1932 by 1910 pixels; color fundus photograph.
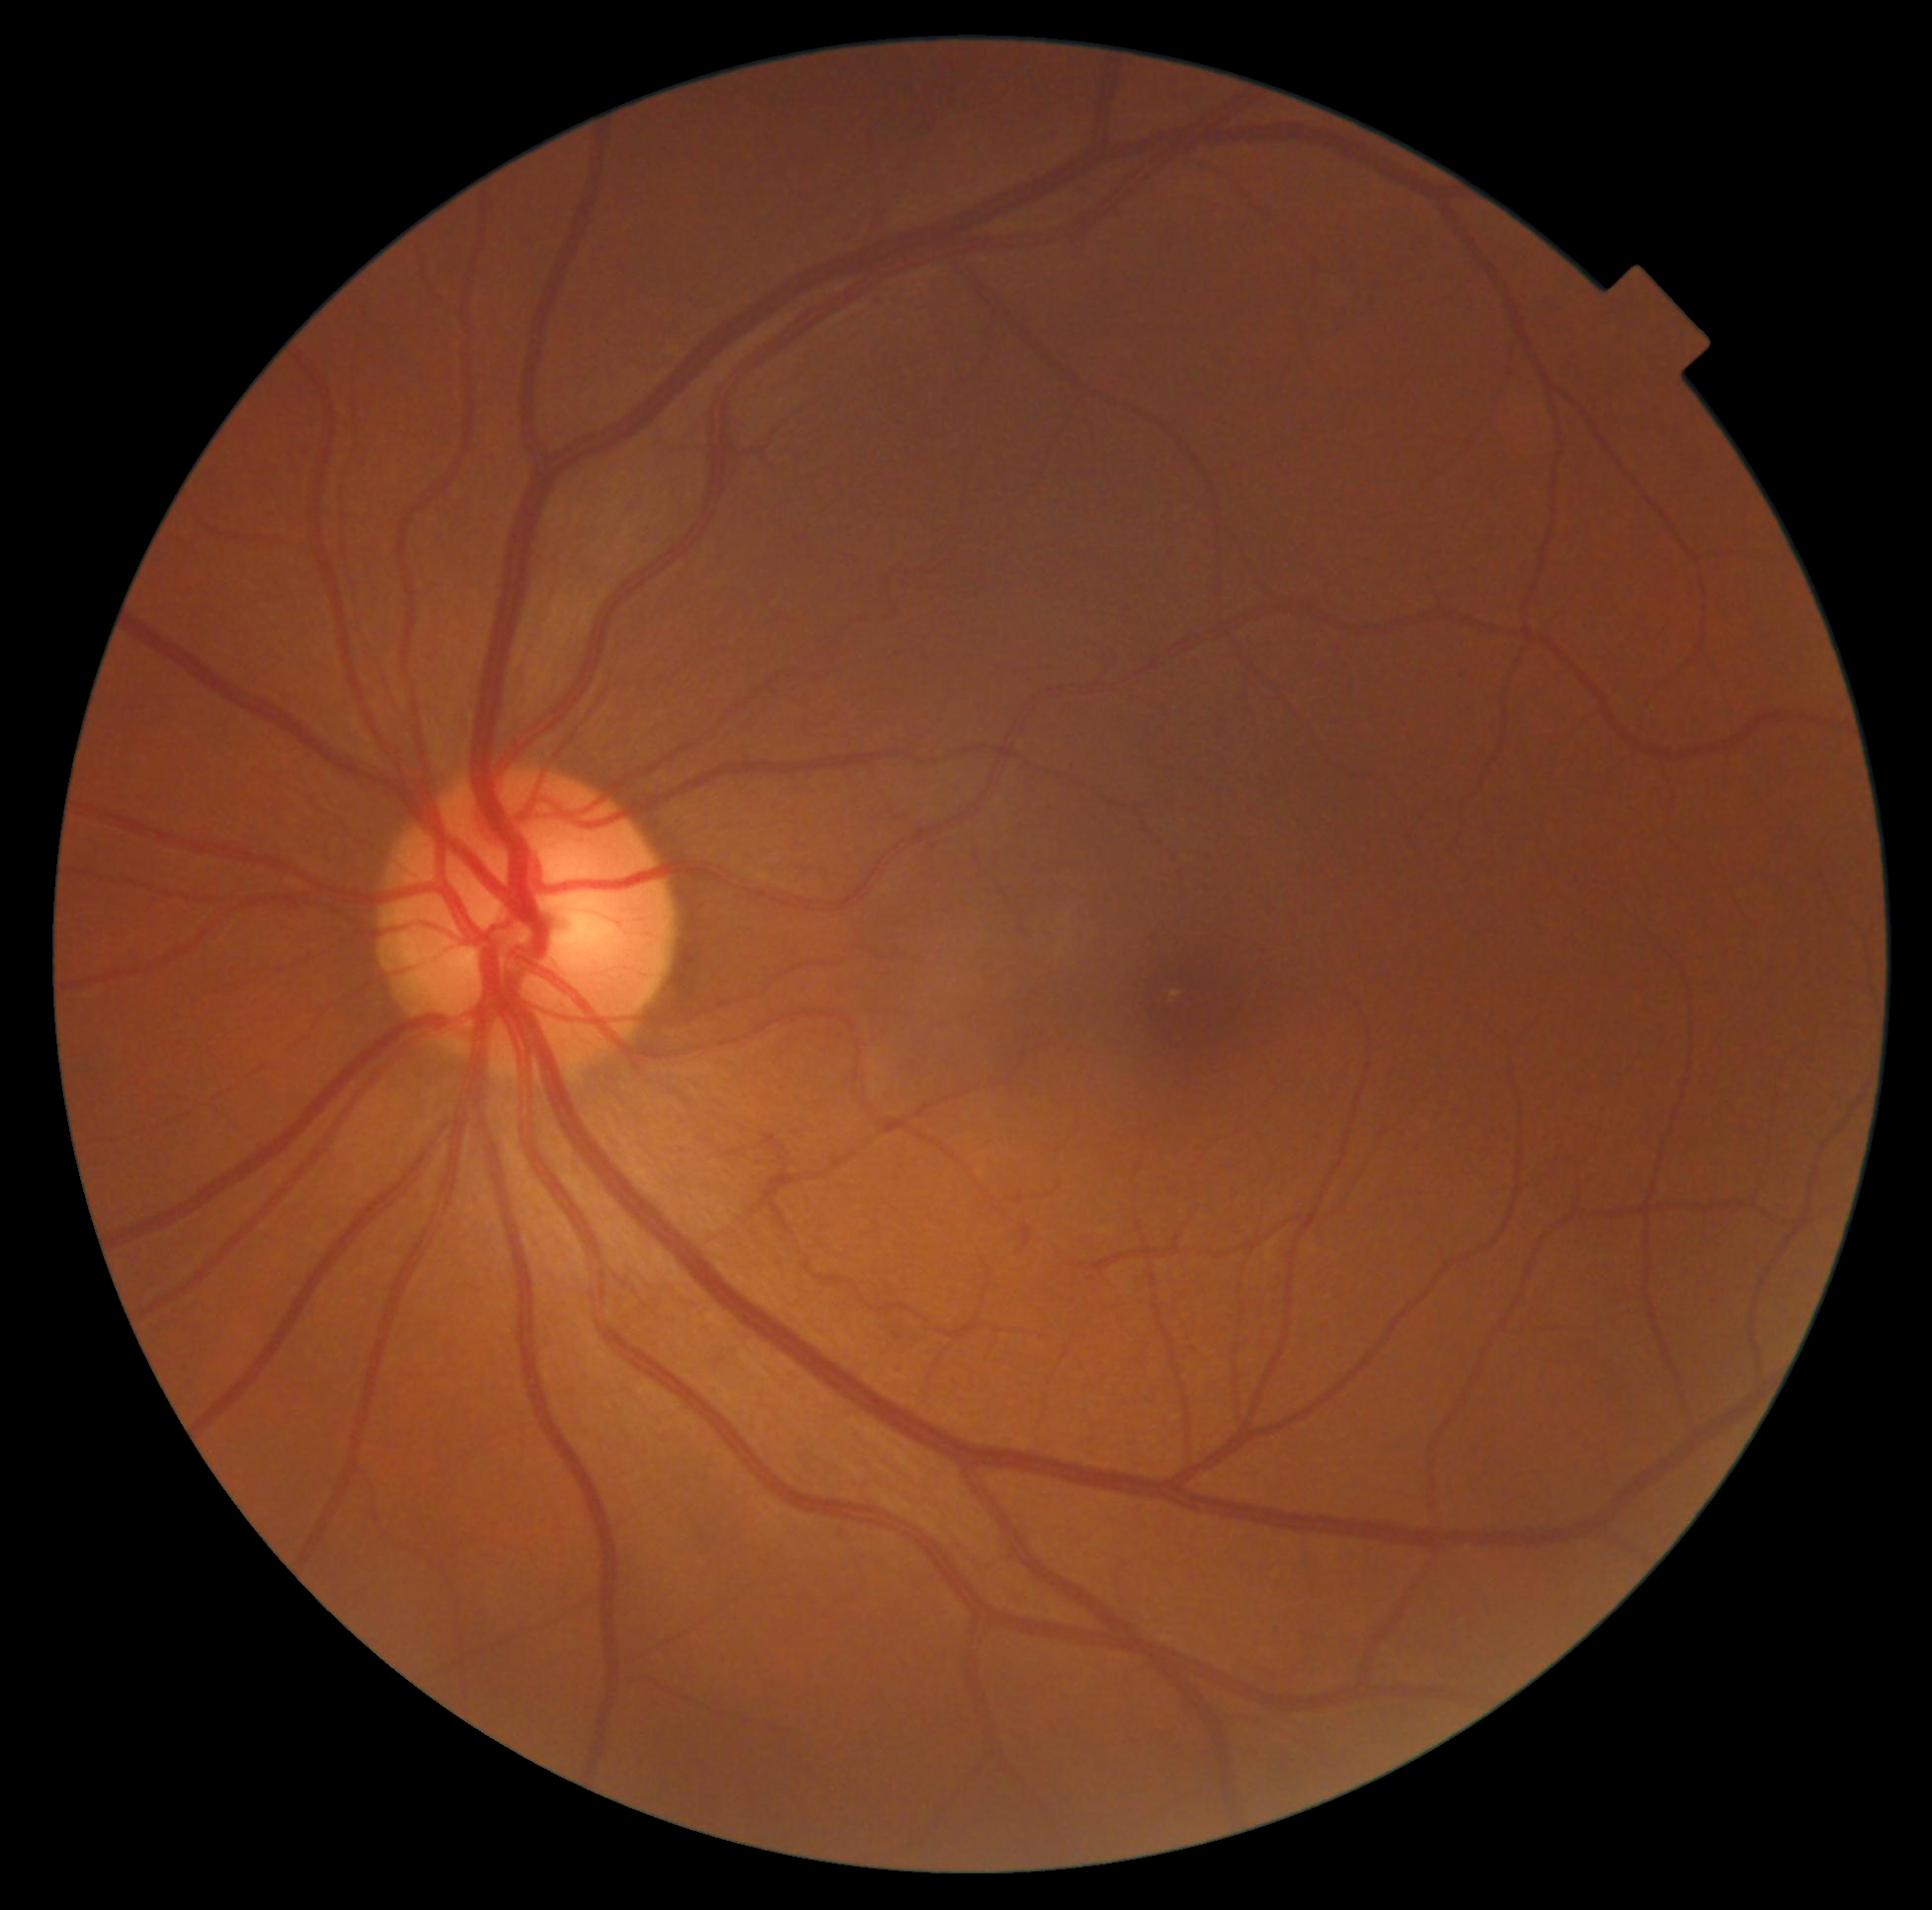
DR grade: 0/4.